Image size 848x848, 45° field of view, modified Davis grading, CFP, nonmydriatic fundus photograph, camera: NIDEK AFC-230:
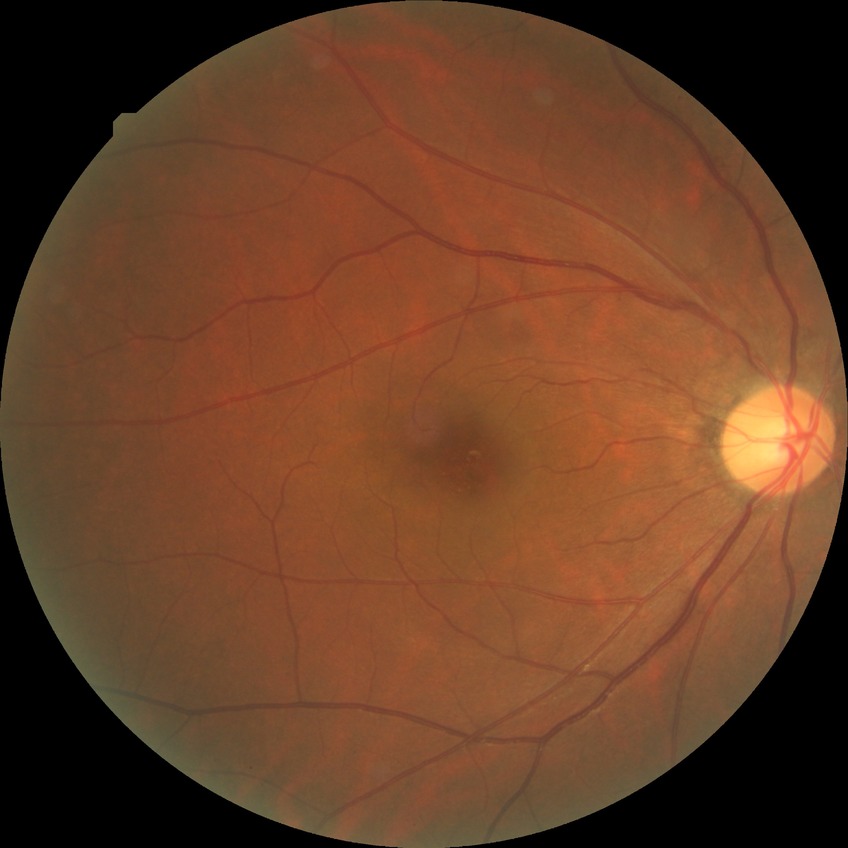

diabetic retinopathy (DR): no diabetic retinopathy (NDR).